Image size 1240x1240; Phoenix ICON, 100° FOV; infant wide-field fundus photograph: 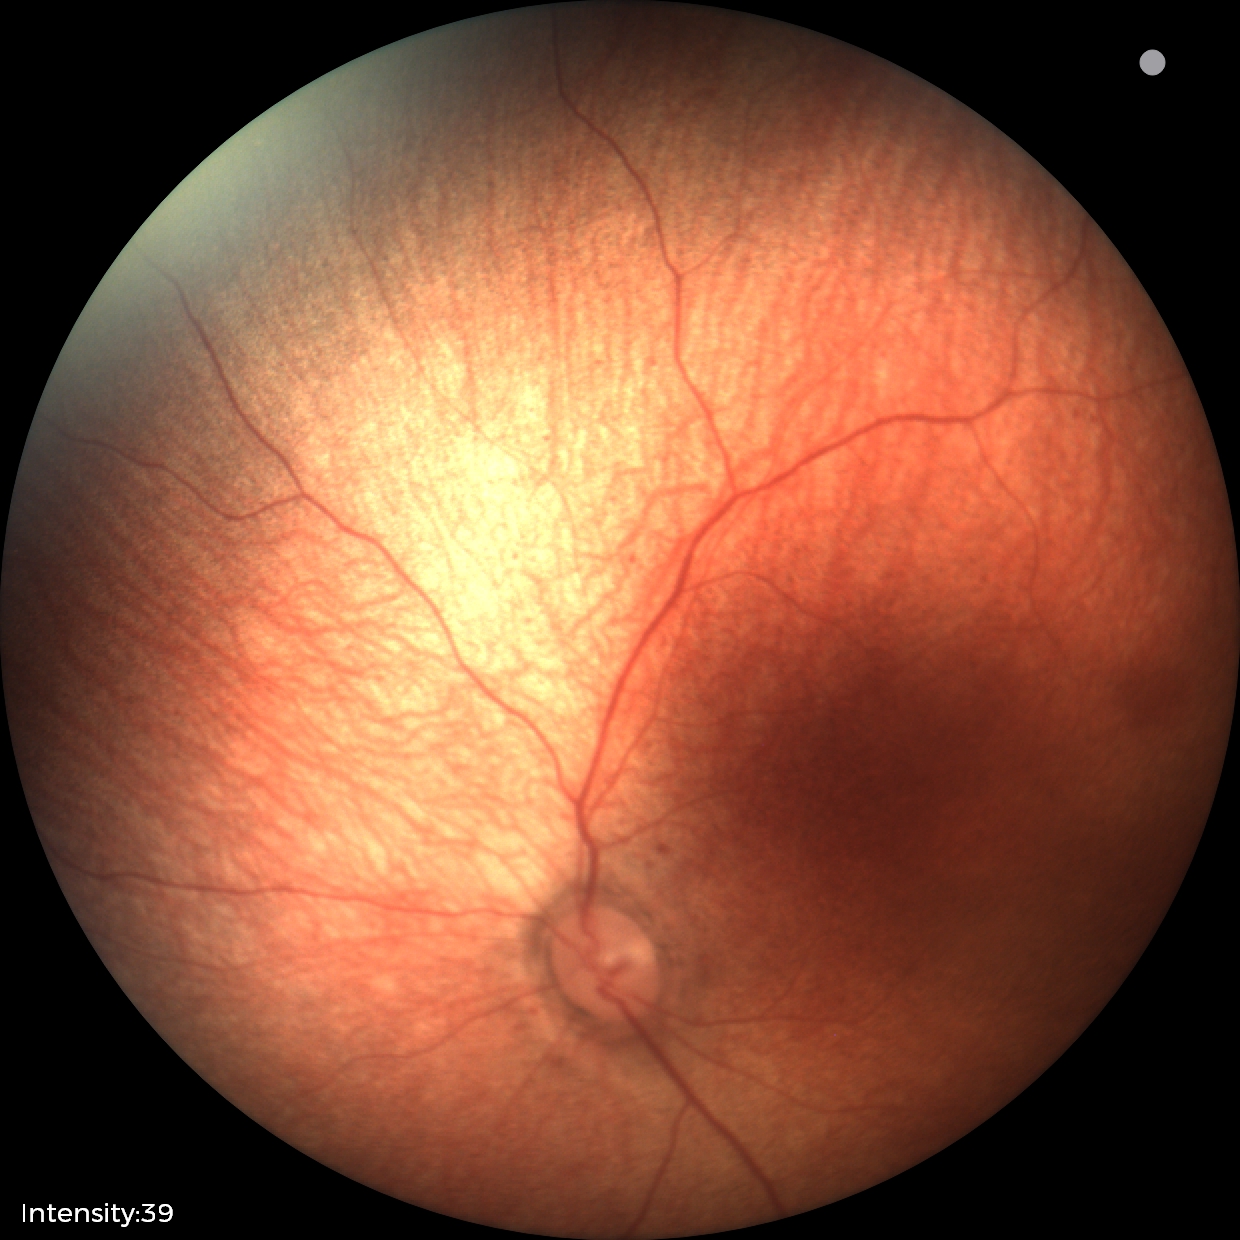

Impression: normal